Infant wide-field retinal image:
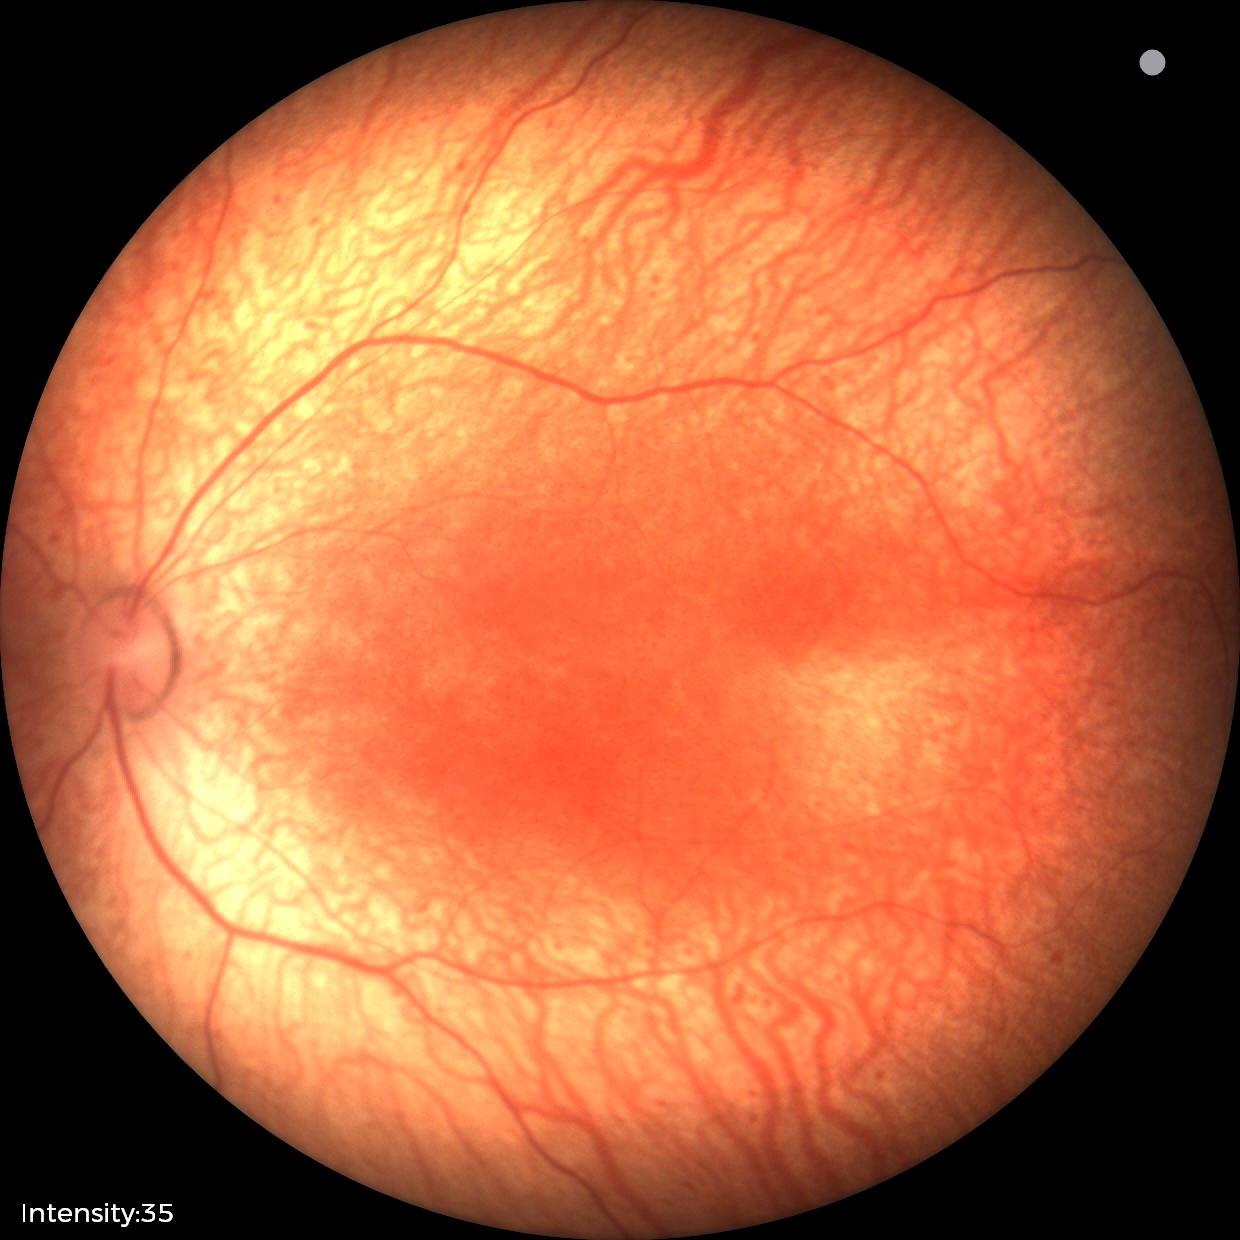
Screening: status post retinopathy of prematurity (ROP) | no plus disease.